FOV: 45 degrees
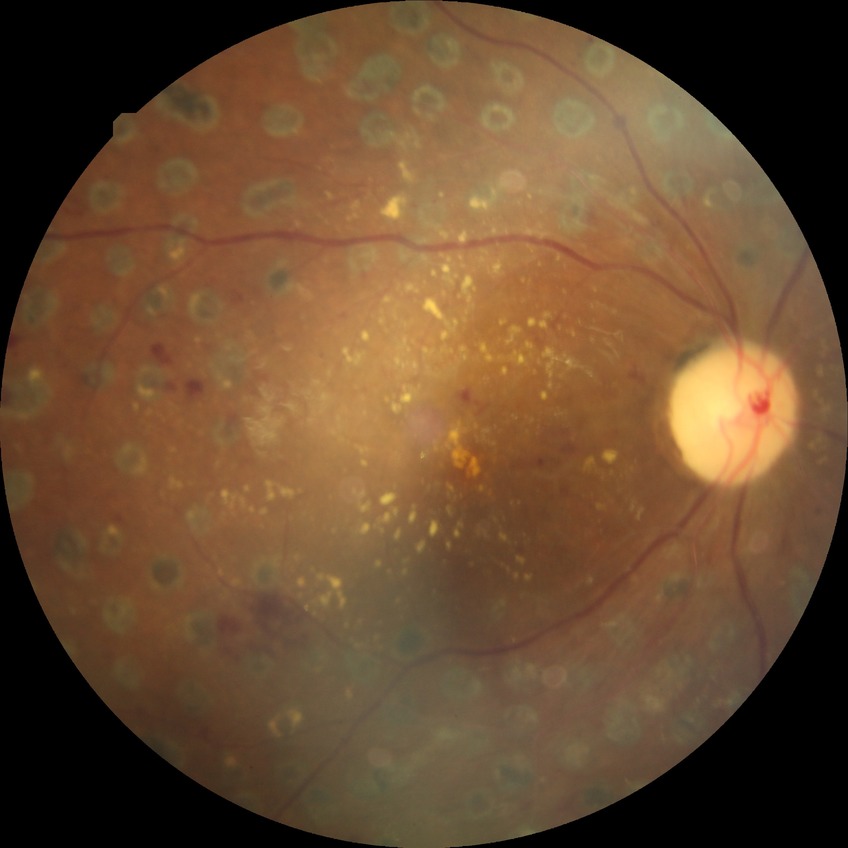

Davis stage: PDR.